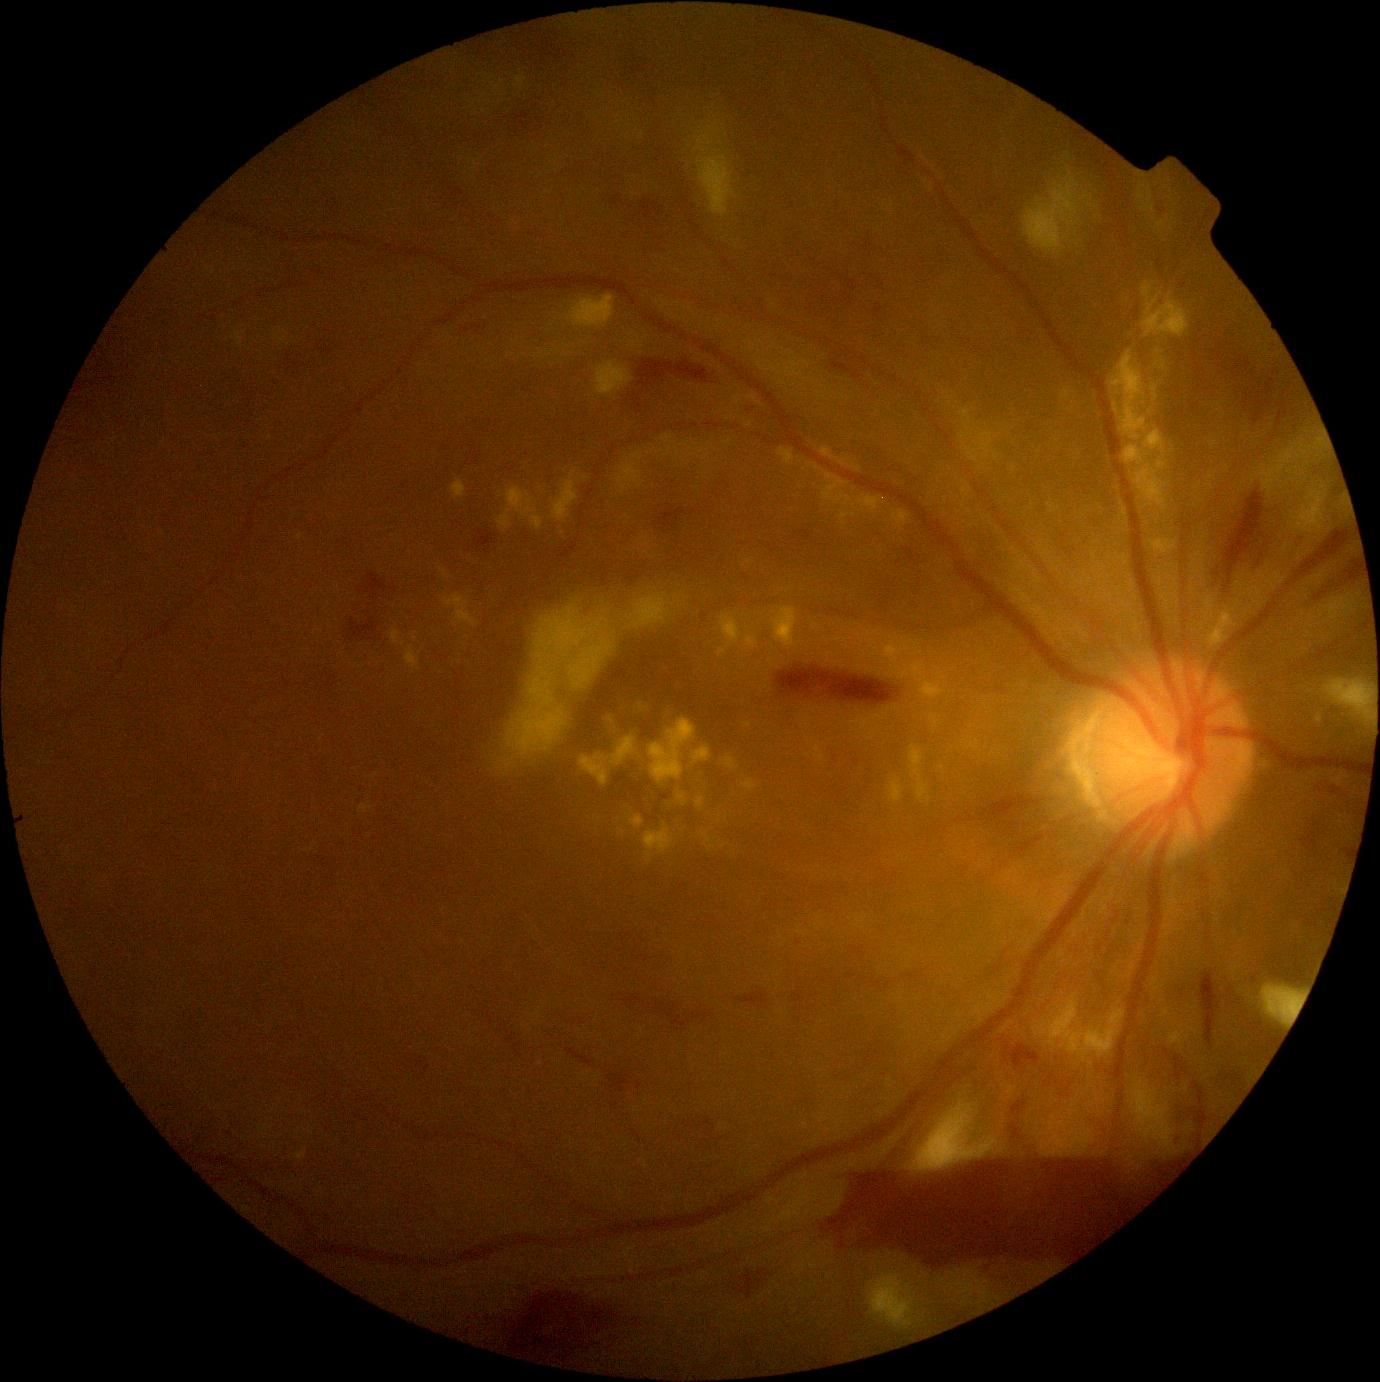

partial: true
dr_grade: 4
dr_grade_name: PDR
lesions:
  ma:
    - region(1011, 1100, 1028, 1116)
    - region(705, 1119, 714, 1127)
    - region(854, 759, 861, 767)
    - region(851, 946, 863, 955)
    - region(1334, 484, 1342, 494)
    - region(1009, 1123, 1021, 1138)
  ma_small:
    - (703; 617)
    - (747; 578)
    - (799; 943)
    - (835; 759)
  se:
    - region(1277, 449, 1293, 475)
    - region(552, 472, 579, 523)
    - region(1316, 438, 1326, 447)
    - region(1067, 153, 1072, 161)
    - region(1156, 220, 1168, 234)
    - region(695, 134, 713, 154)
    - region(1025, 172, 1080, 255)
    - region(567, 294, 616, 329)
    - region(698, 150, 735, 219)
    - region(489, 589, 679, 782)
    - region(1264, 987, 1302, 1025)
  se_small:
    - (1149; 190)
    - (1290; 473)
    - (1076; 234)
    - (1087; 197)
  ex:
    - region(725, 440, 733, 445)
    - region(967, 740, 979, 751)
    - region(893, 510, 911, 525)
    - region(1114, 403, 1120, 414)
    - region(746, 637, 759, 650)
    - region(361, 805, 373, 813)
    - region(617, 451, 645, 495)
    - region(1142, 282, 1190, 339)
    - region(1036, 995, 1126, 1061)
    - region(405, 646, 421, 672)
    - region(1209, 610, 1238, 647)
    - region(612, 738, 636, 766)
    - region(498, 510, 513, 532)
    - region(931, 717, 939, 724)
  ex_small:
    - (648; 453)
    - (809; 465)
    - (696; 445)
    - (612; 720)
    - (843; 463)
  he:
    - region(1223, 490, 1265, 594)
    - region(1091, 1099, 1149, 1154)
    - region(1005, 1042, 1041, 1069)
    - region(475, 530, 496, 553)
    - region(1292, 531, 1312, 552)
    - region(824, 1155, 1180, 1266)
    - region(637, 360, 713, 389)
    - region(1200, 972, 1221, 1046)
    - region(566, 1049, 594, 1068)
    - region(657, 1000, 714, 1030)
    - region(735, 992, 768, 1010)
    - region(1234, 359, 1296, 437)